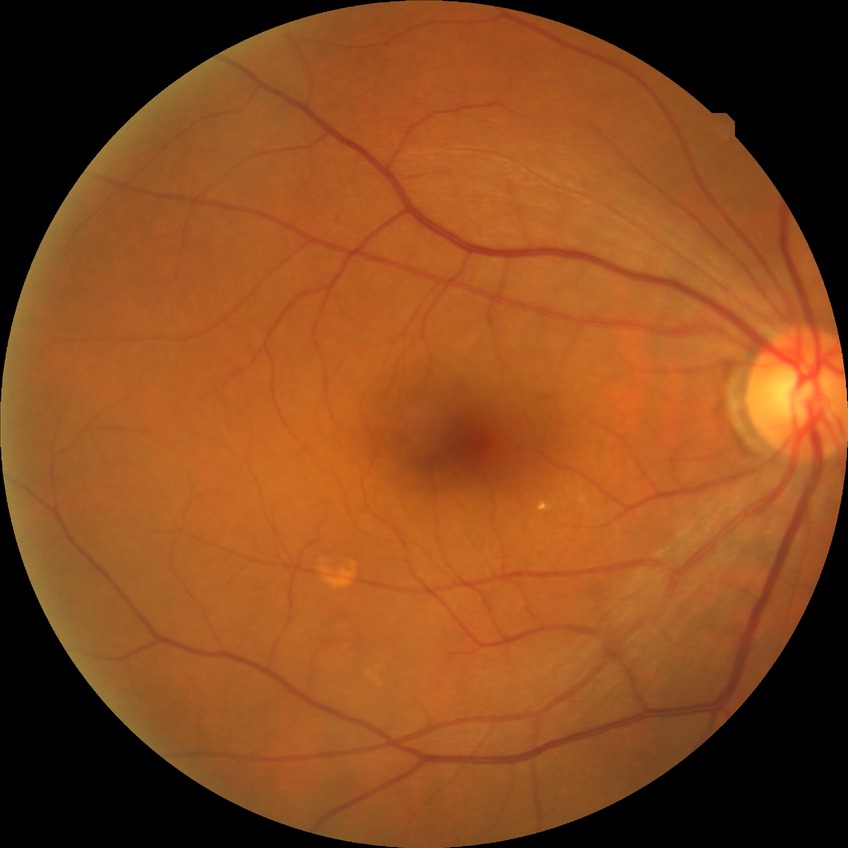 Diabetic retinopathy (DR): no diabetic retinopathy (NDR).